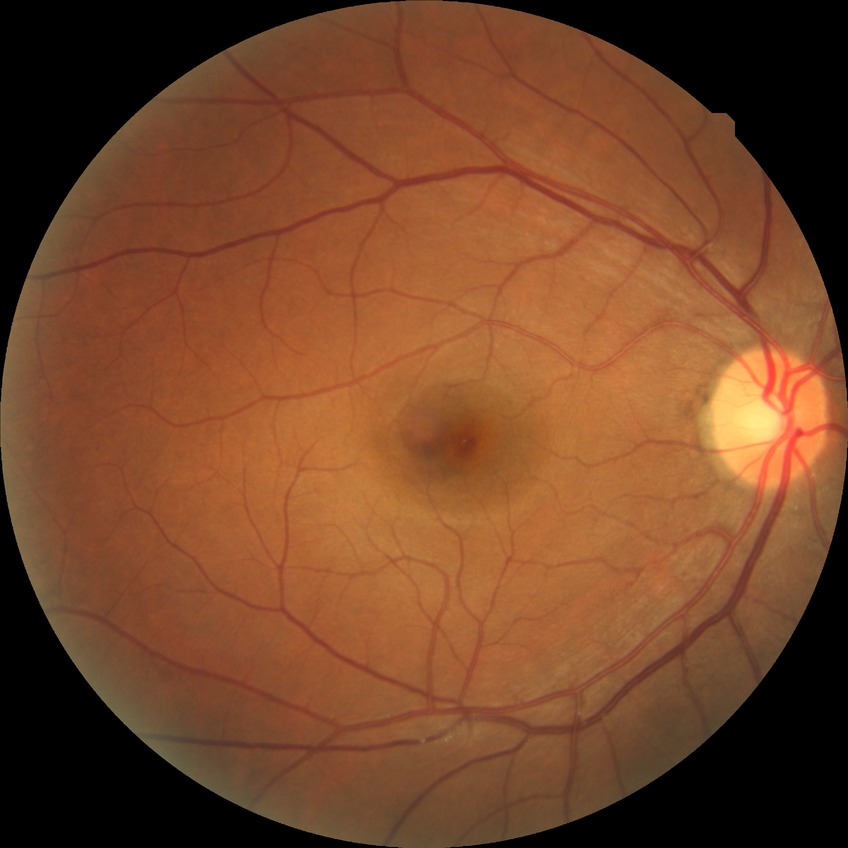

{
  "davis_grade": "NDR (no diabetic retinopathy)"
}